Color fundus photograph.
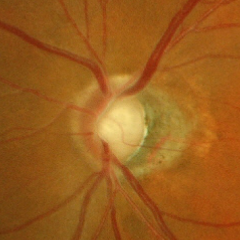
Glaucoma is present.
Early-stage glaucoma.